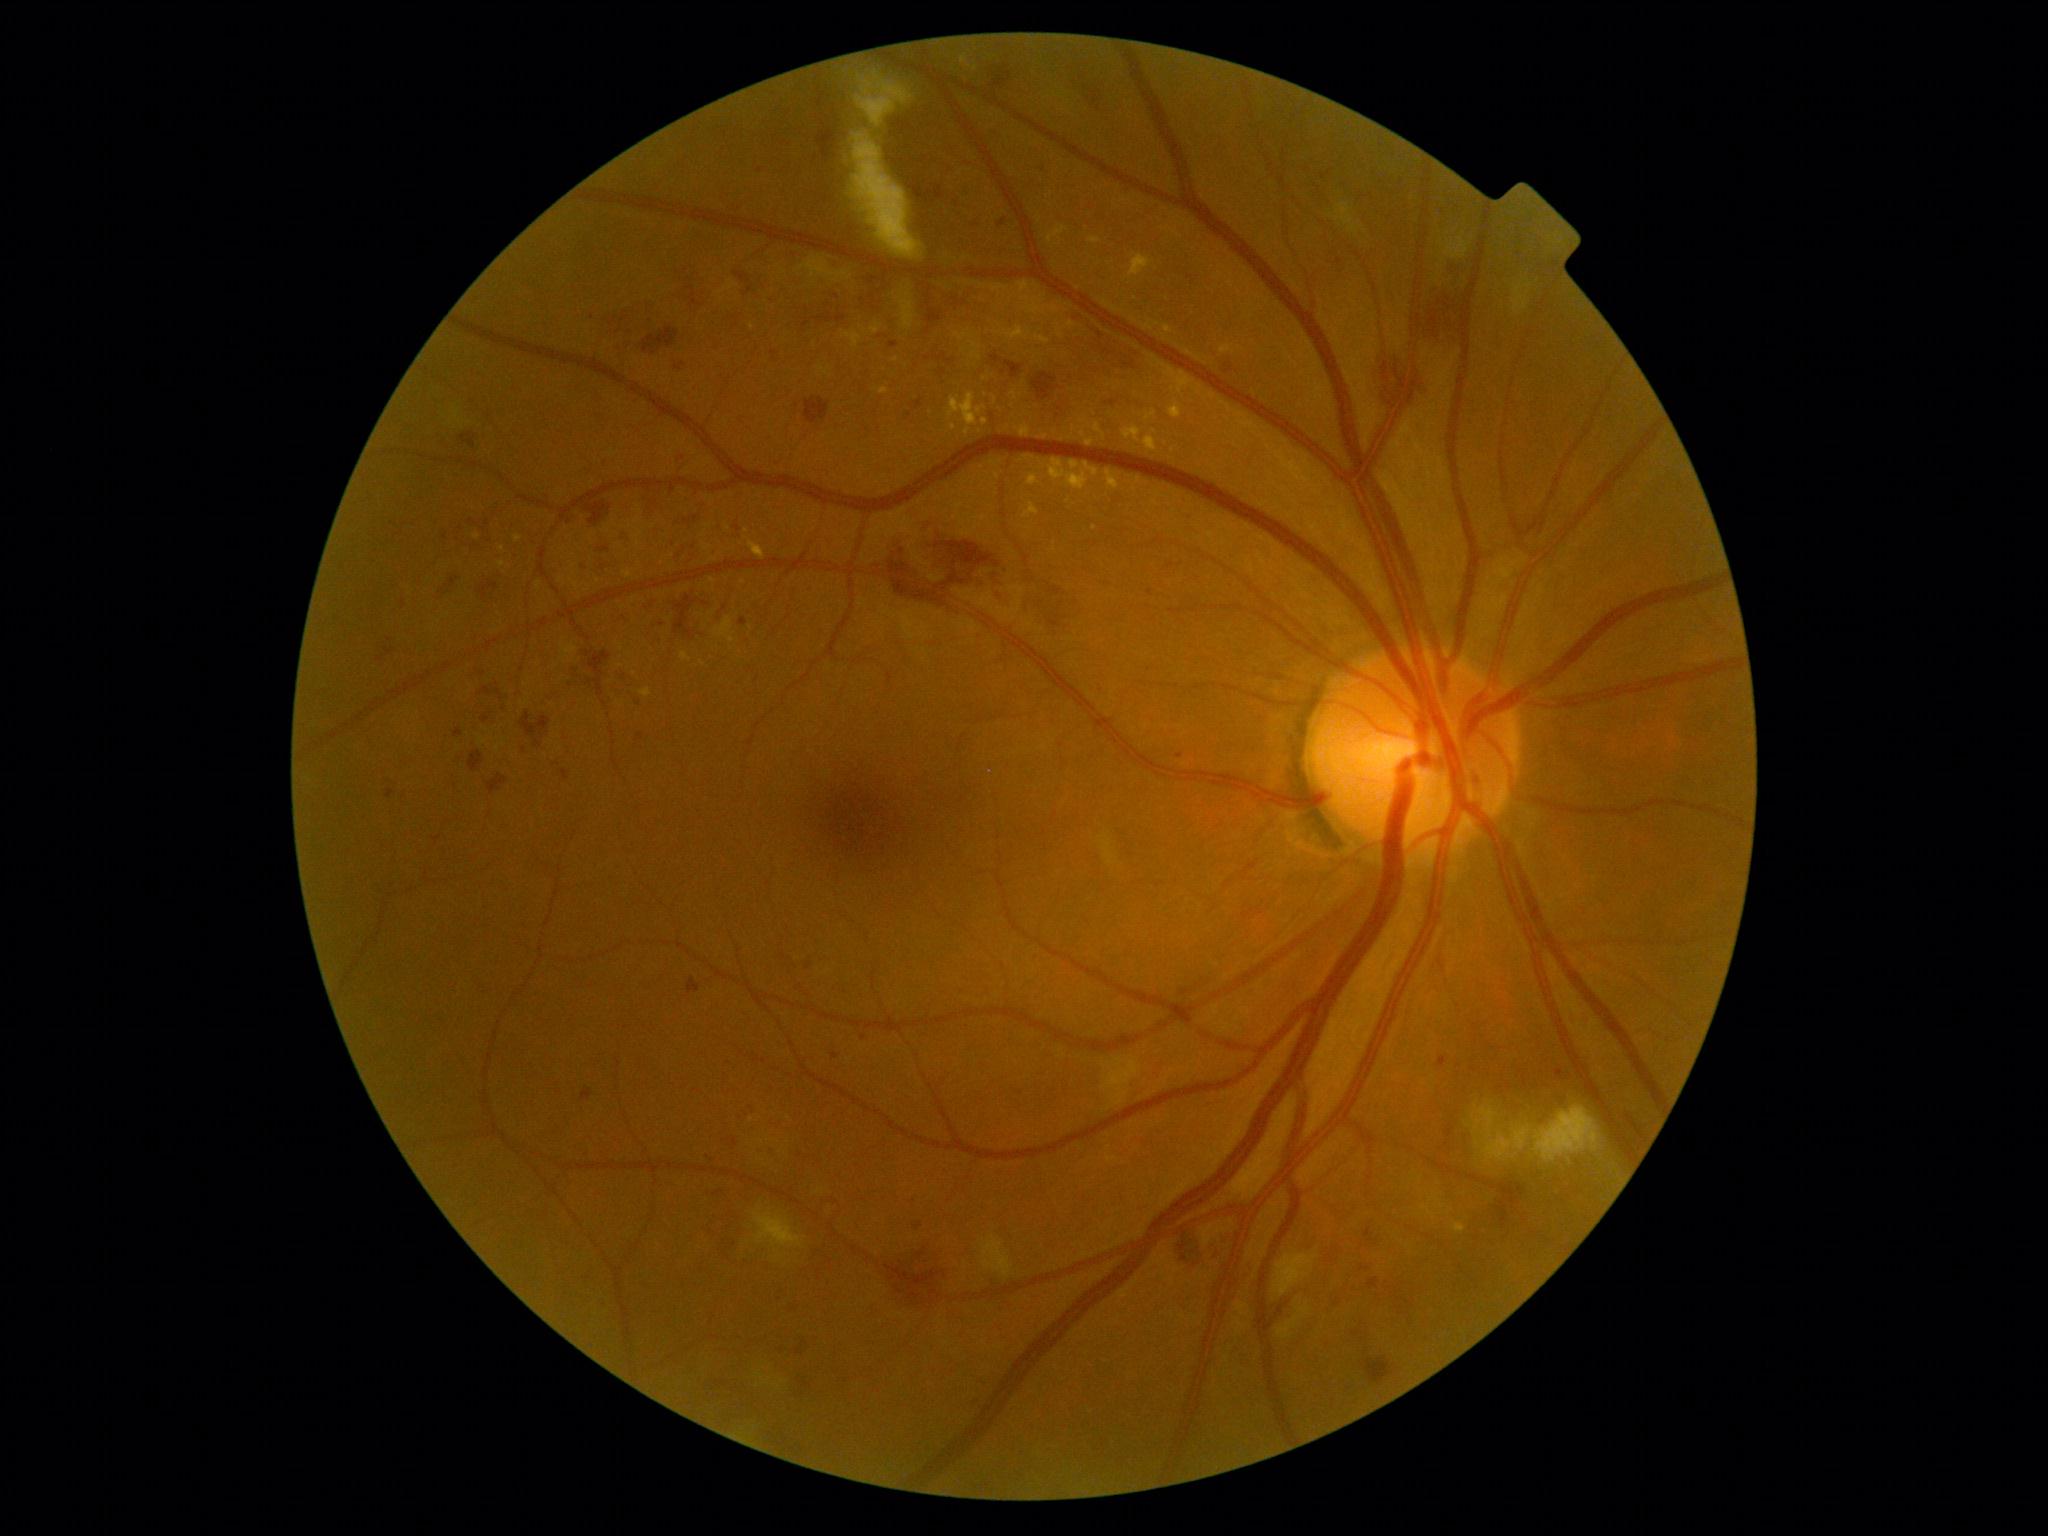 retinopathy grade@severe non-proliferative diabetic retinopathy (3).